Retinal fundus photograph, 45° field of view
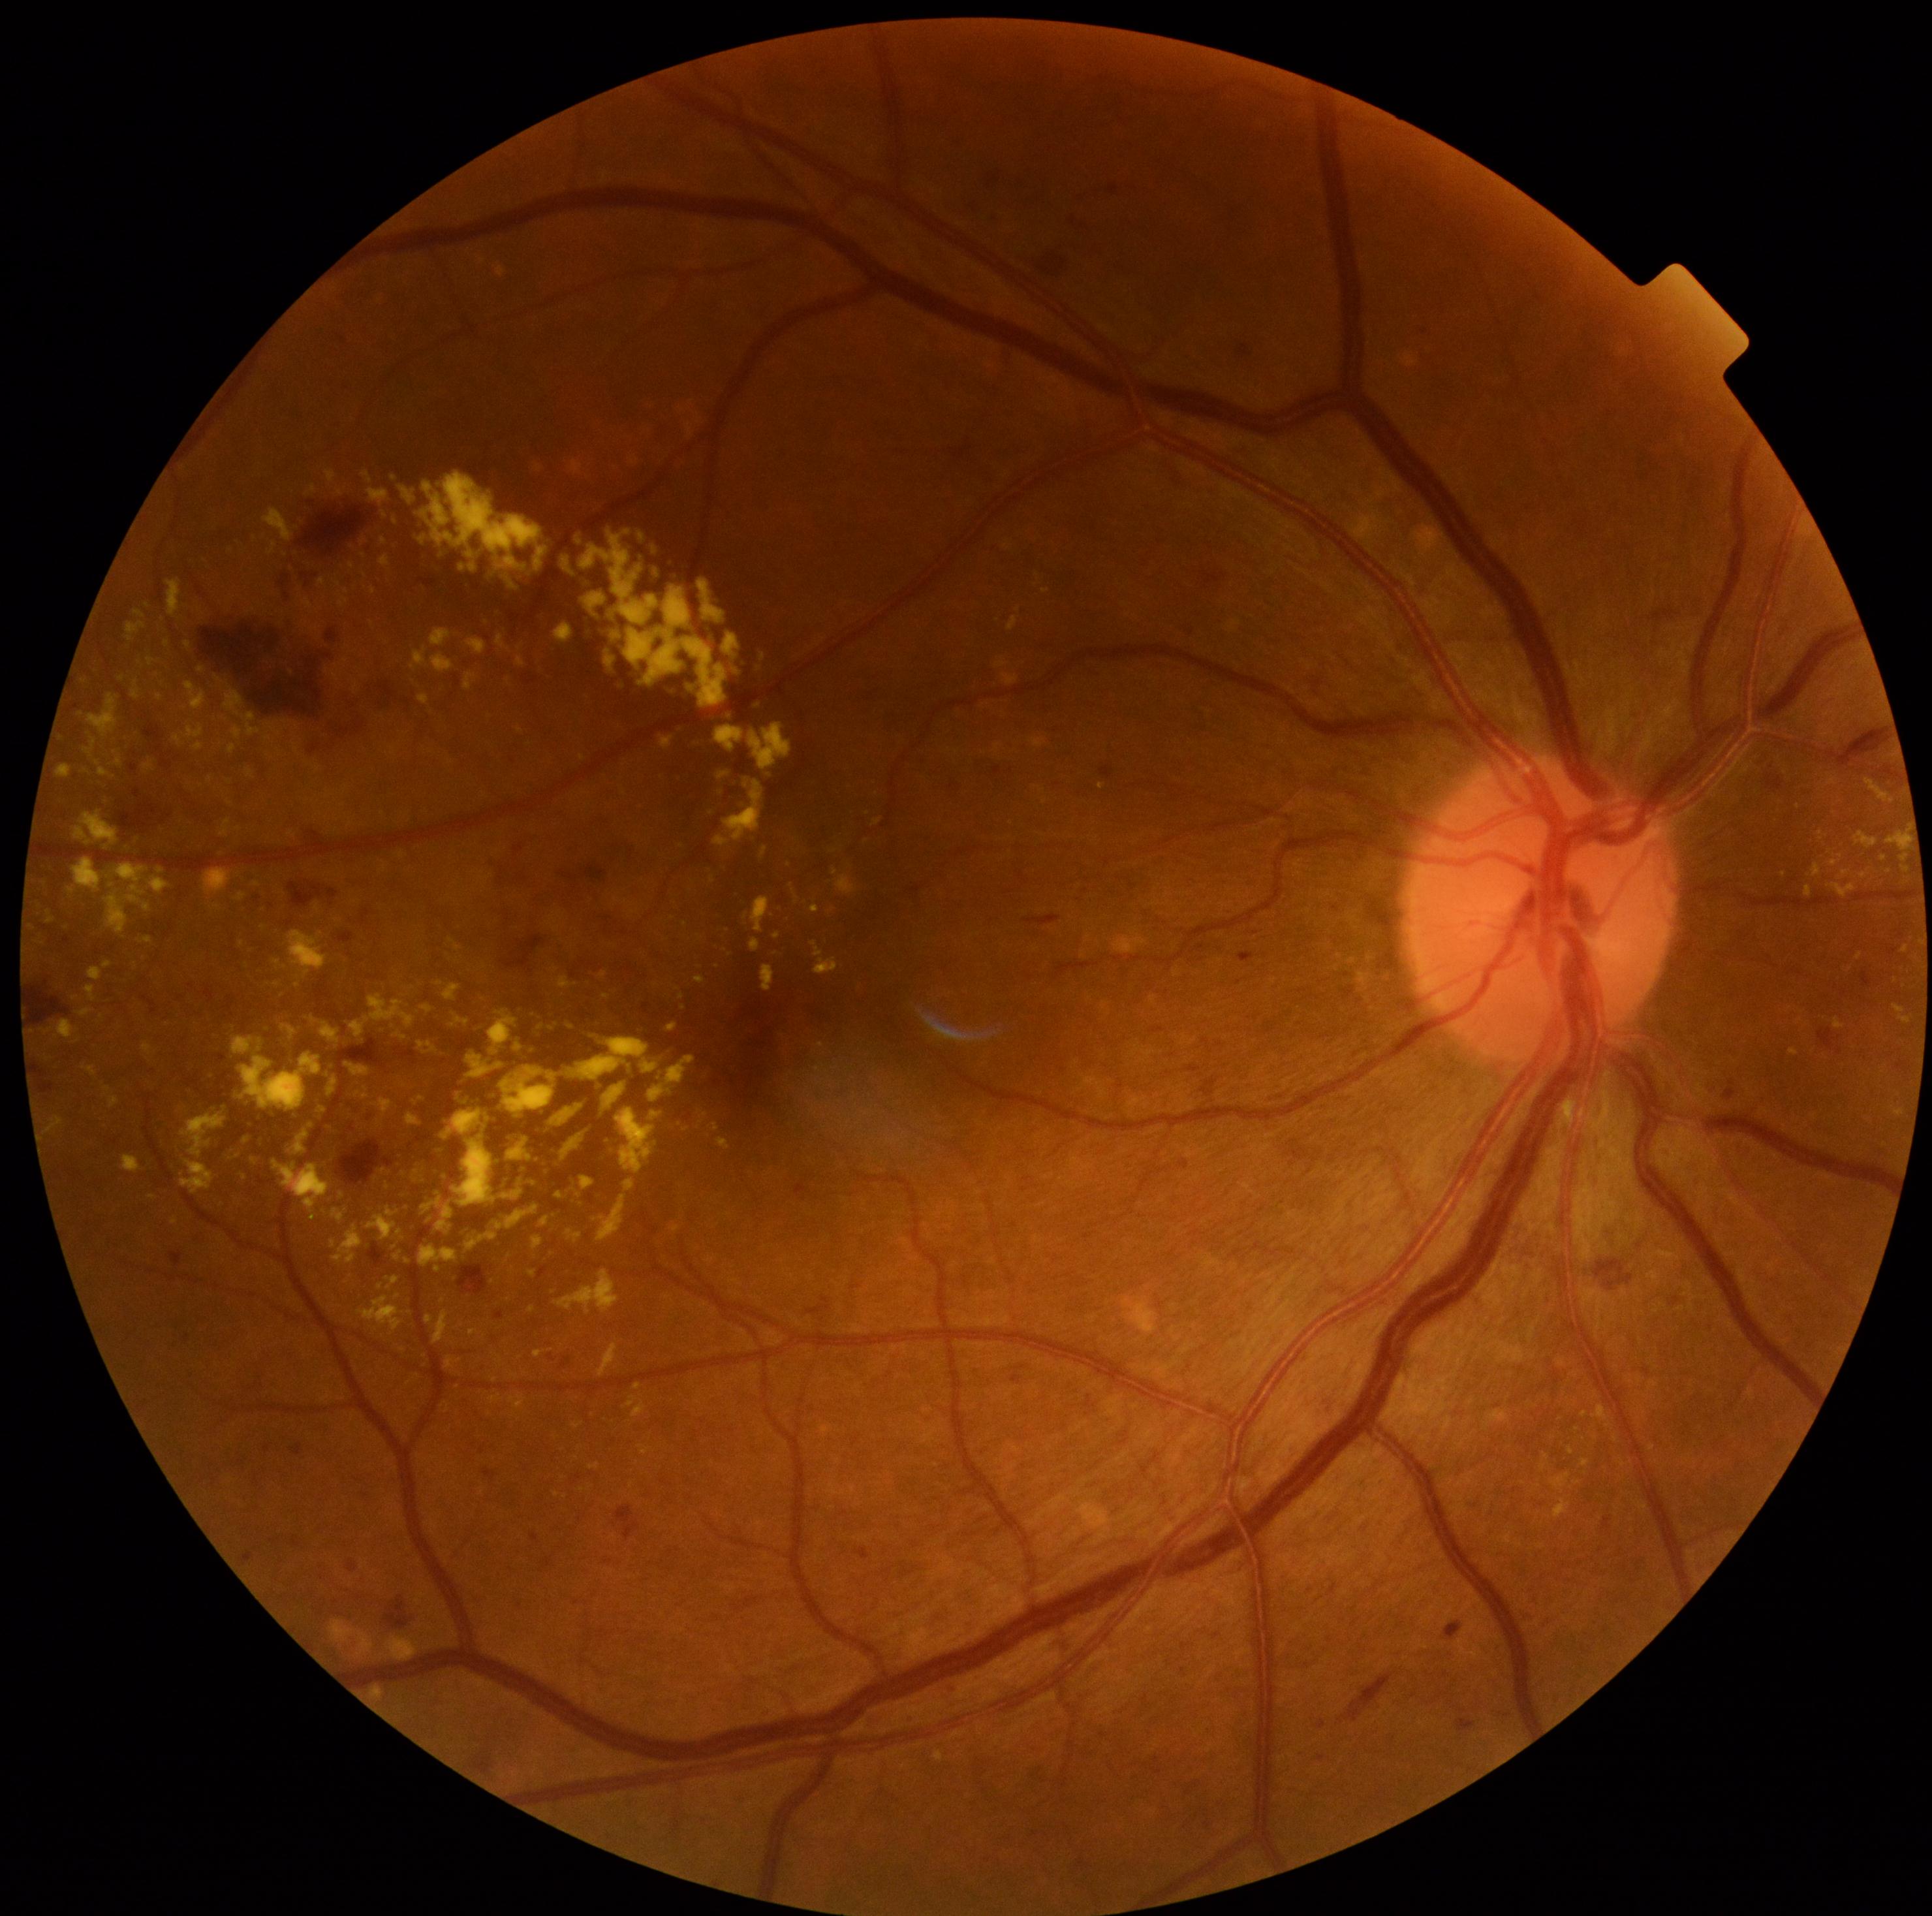 partial: true
dr_grade: 2
dr_grade_name: moderate NPDR
lesions:
  ex:
    - (104,961,112,969)
    - (632,1401,647,1418)
    - (495,1355,503,1366)
    - (773,932,781,939)
    - (811,906,820,913)
    - (837,876,857,894)
    - (582,1176,595,1191)
    - (1570,1479,1579,1490)
    - (699,580,725,624)
    - (339,594,348,610)
    - (69,856,172,939)
    - (606,654,615,667)
    - (185,682,207,710)
  ex_small_centers:
    - 1610:1425
    - 381:1286
    - 263:928
    - 1596:1437
    - 1841:857
    - 364:543
    - 148:605